2184x1690:
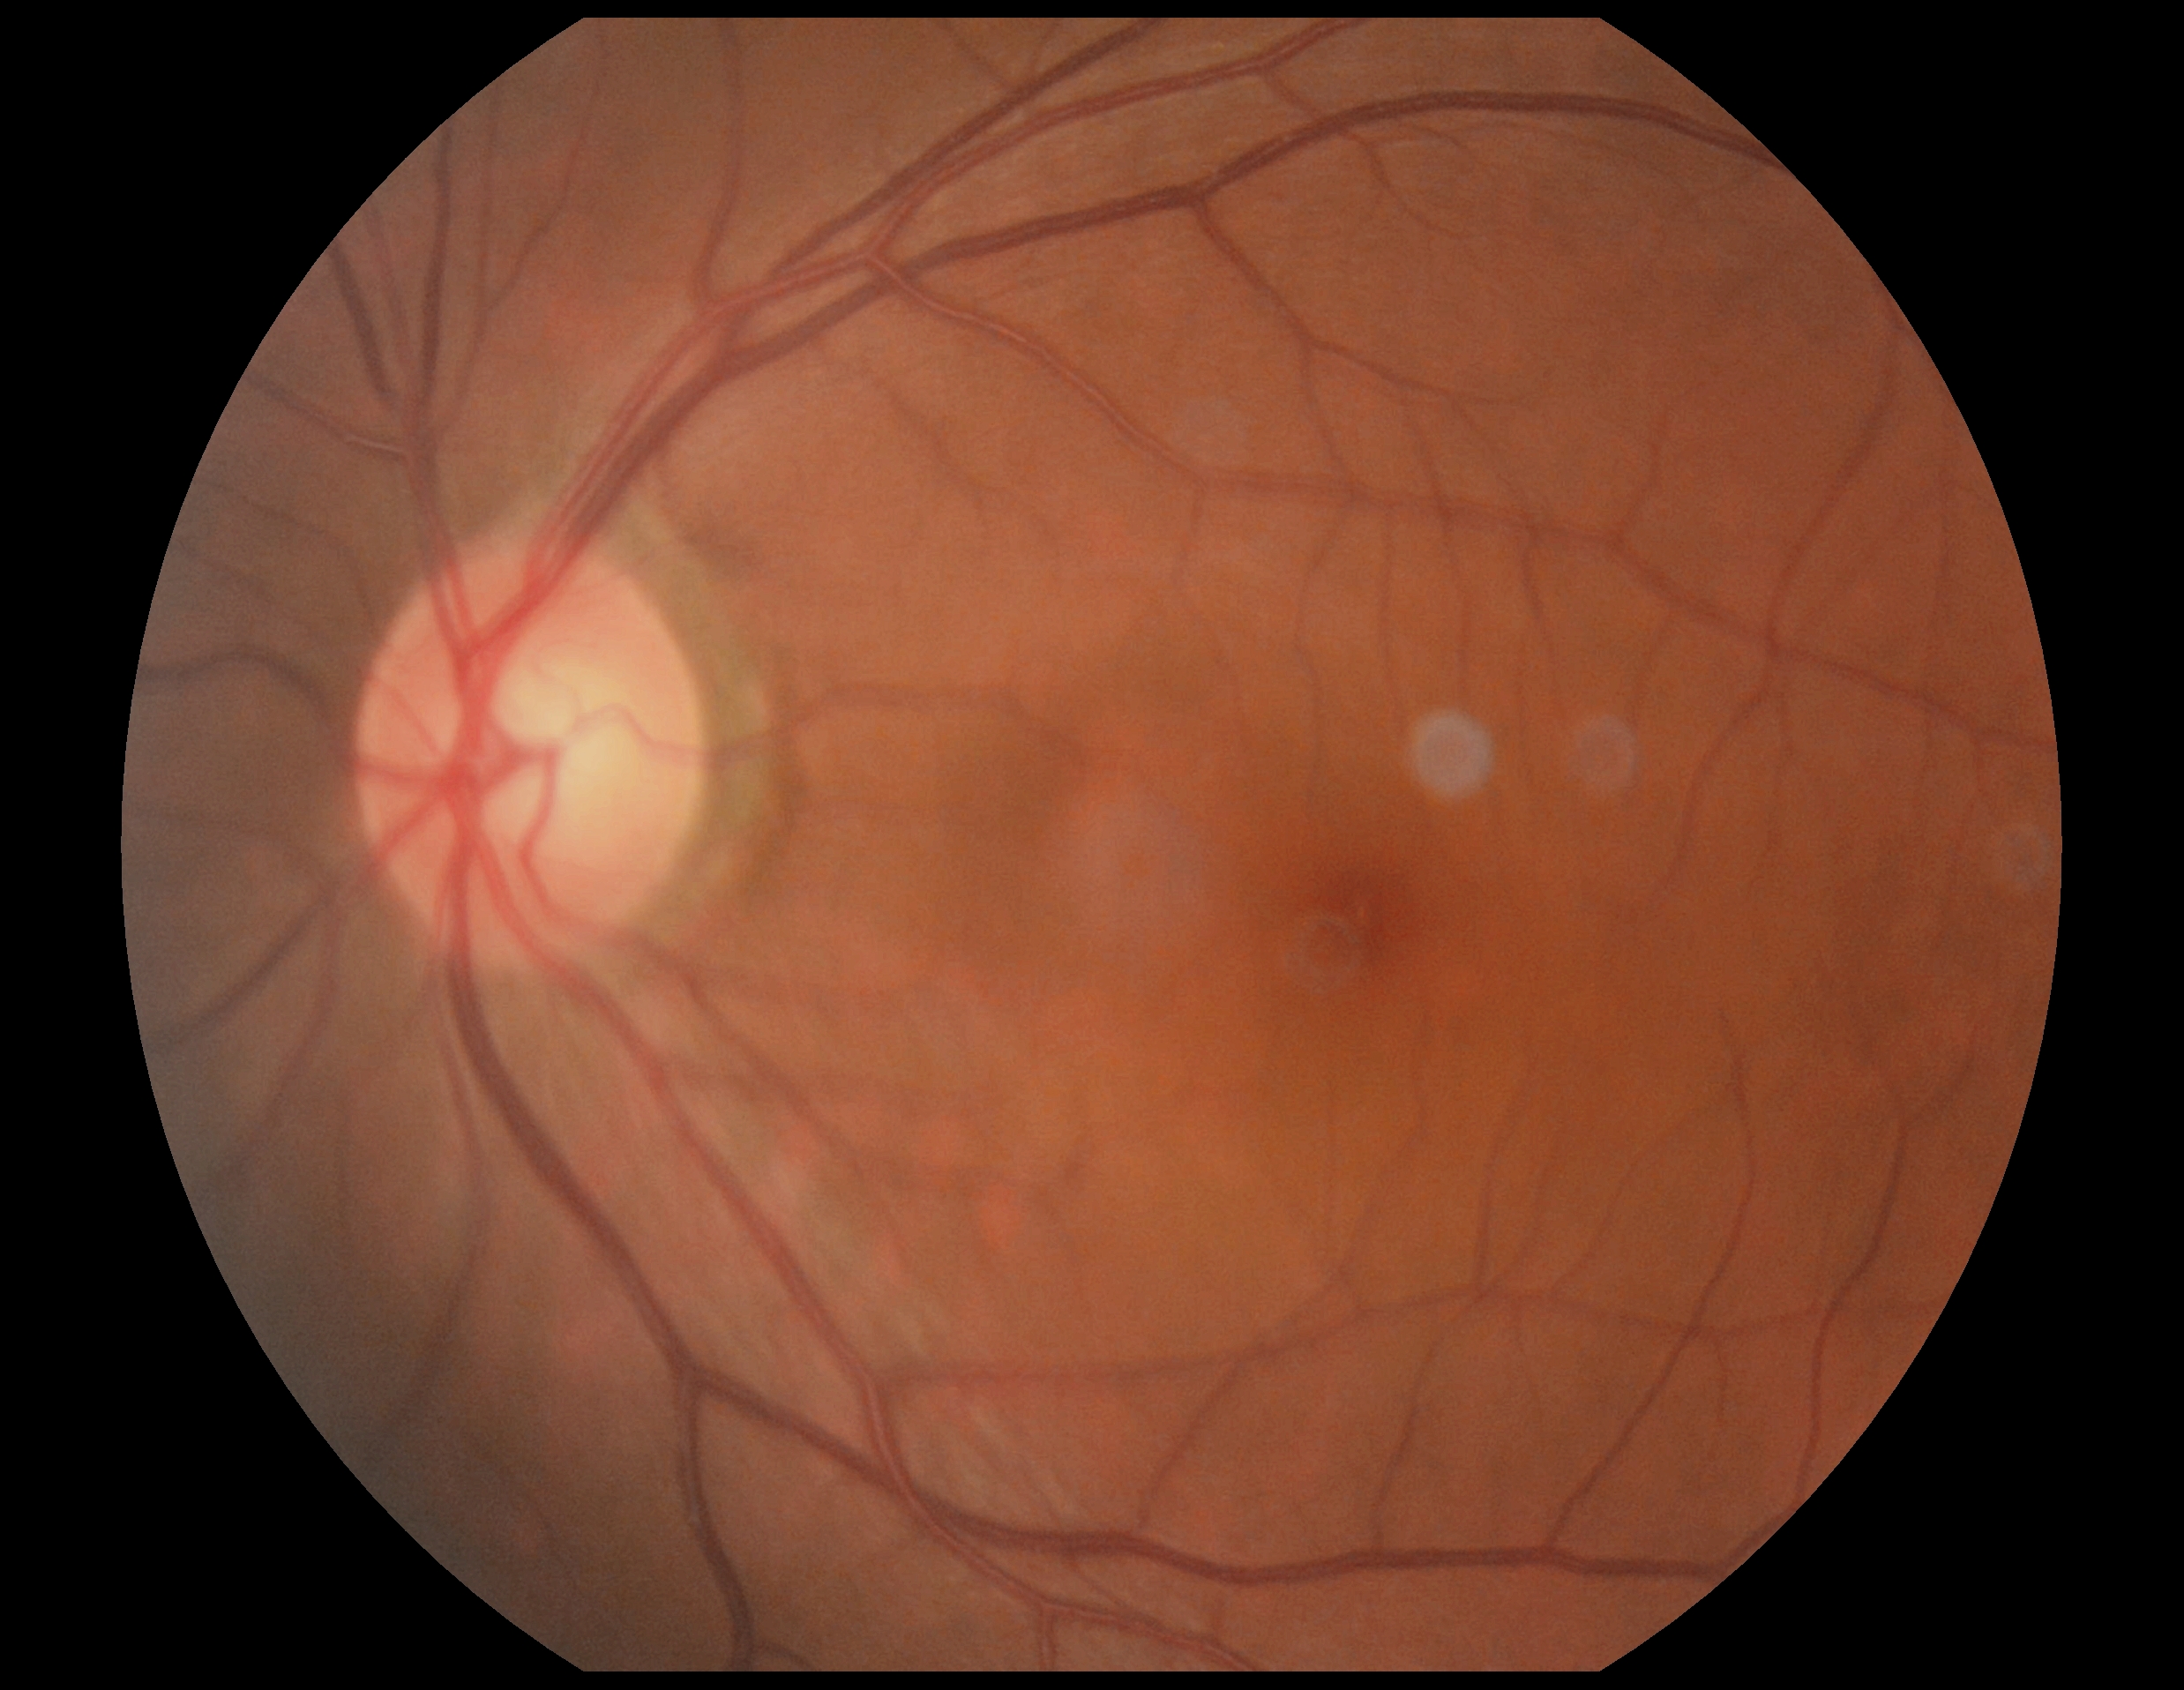

DR: no apparent retinopathy (grade 0).
No apparent diabetic retinopathy.